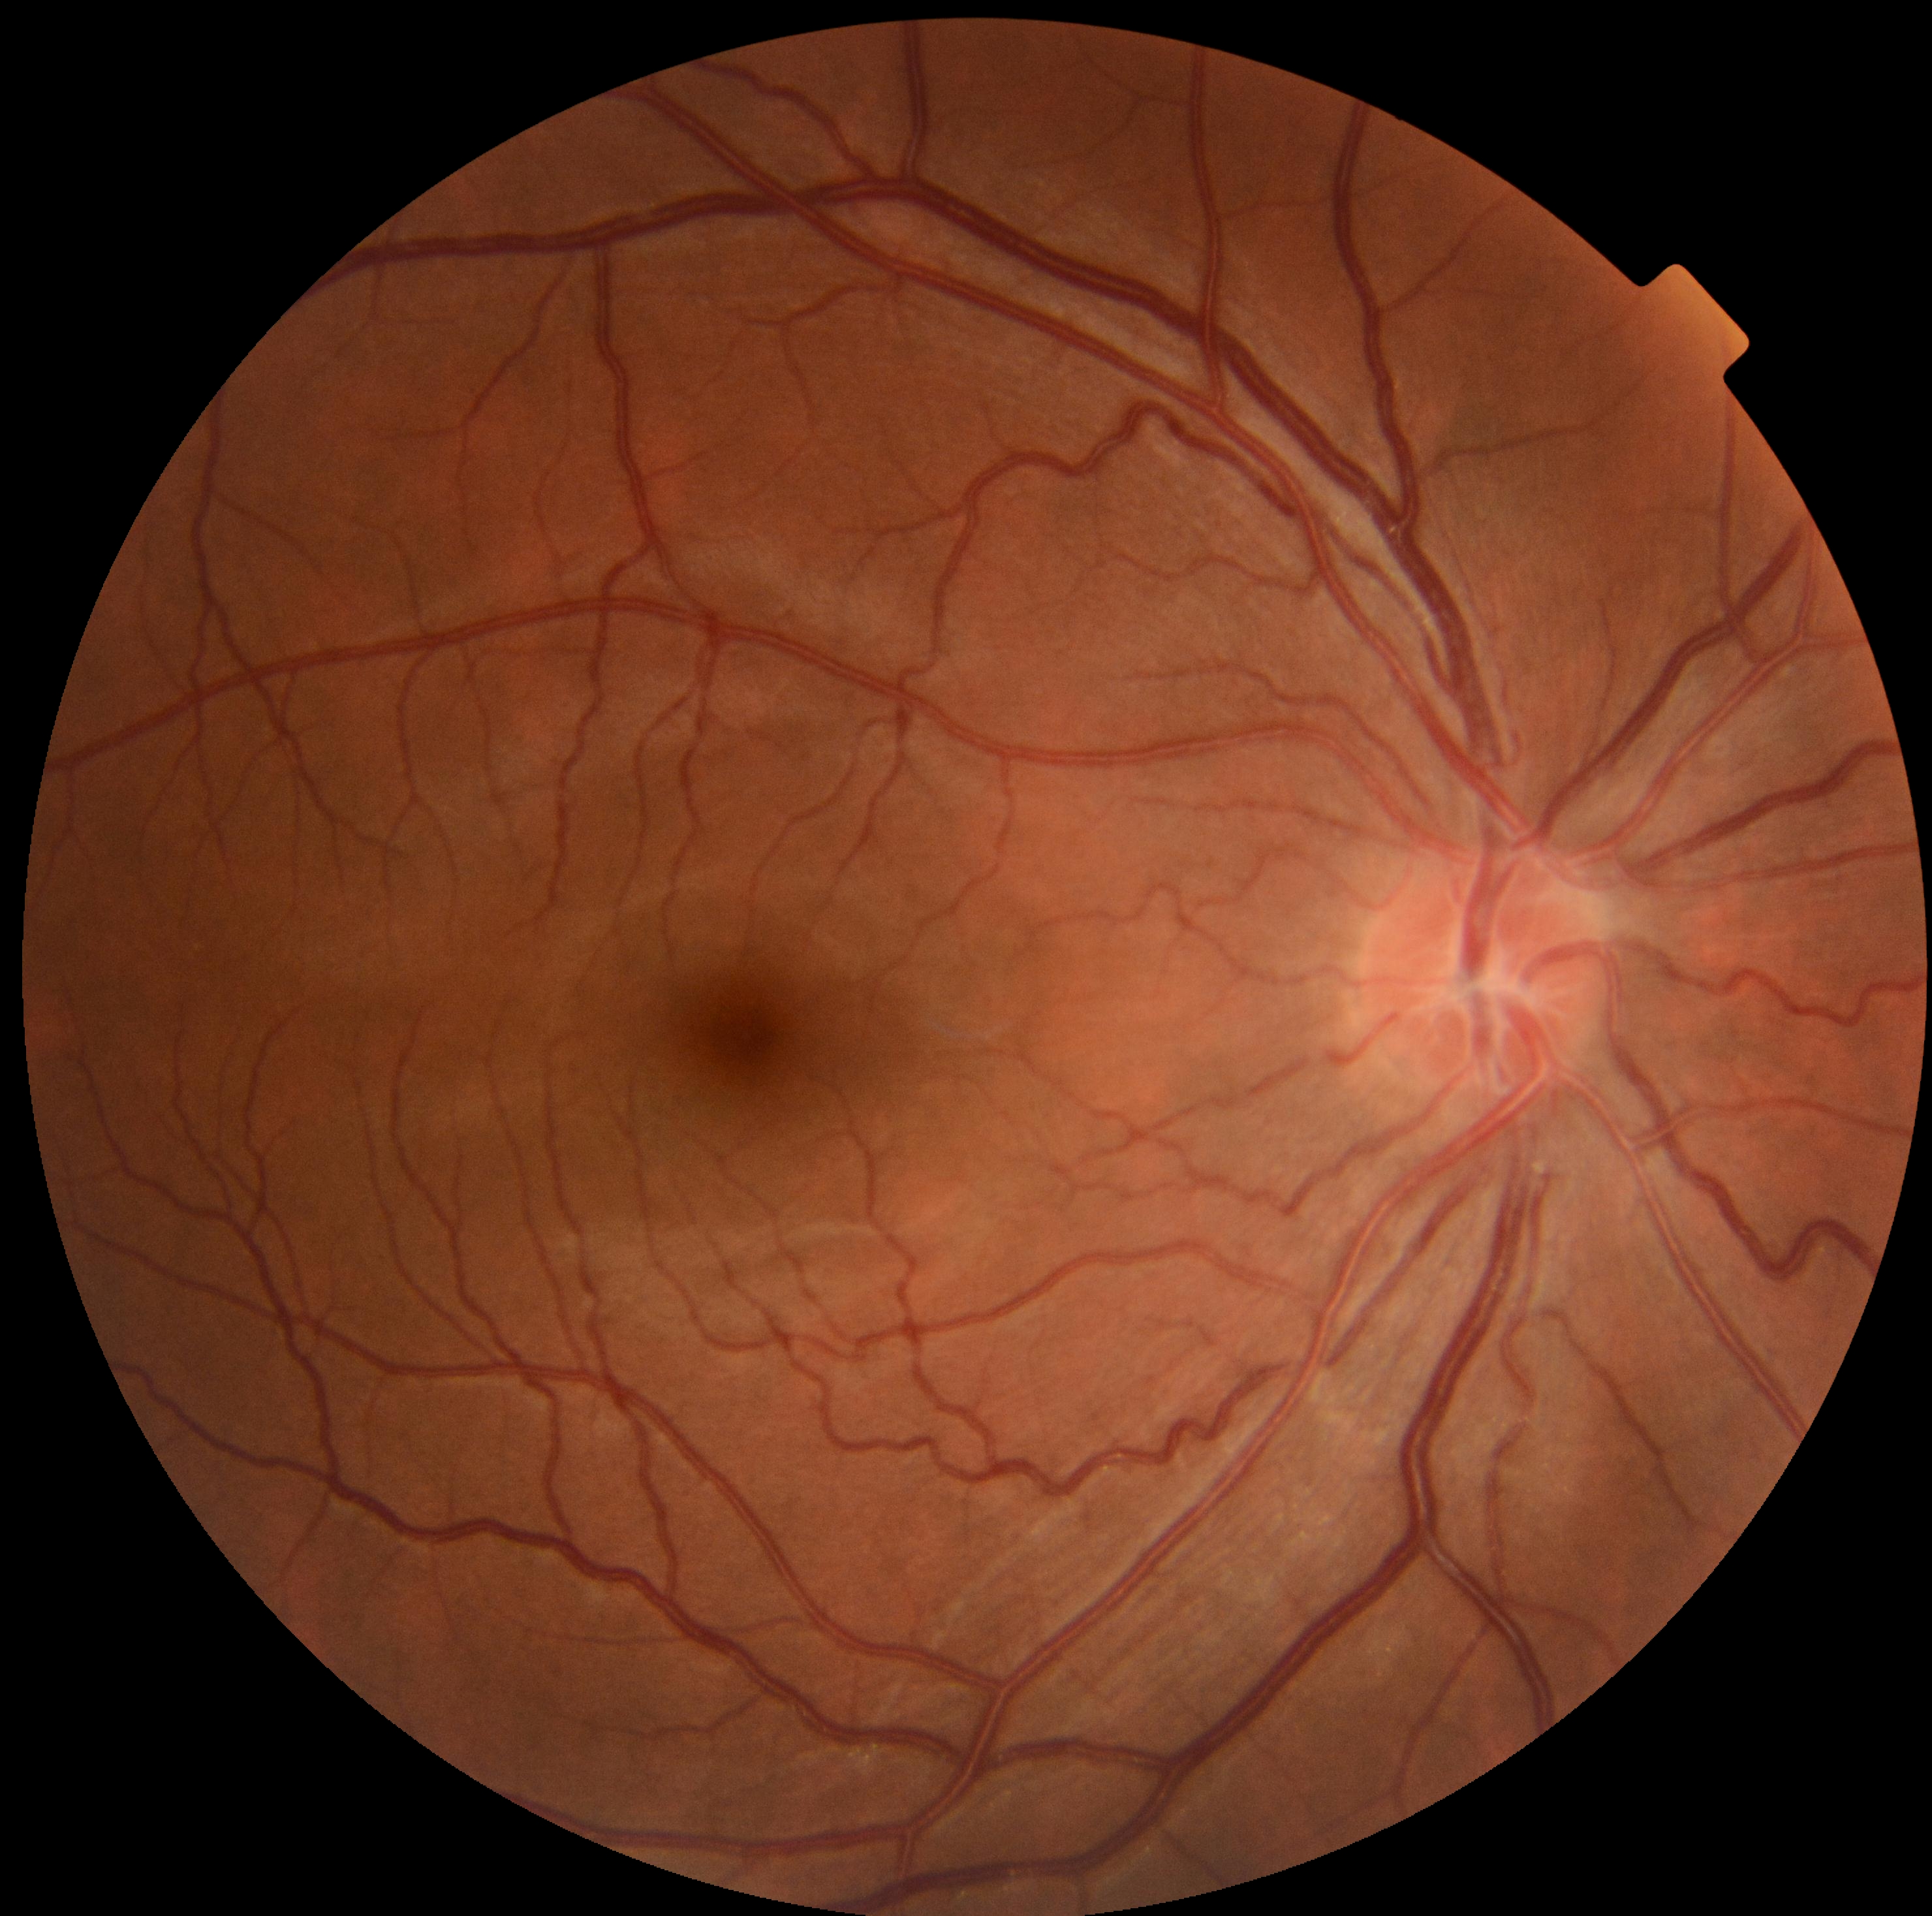 DR grade is no apparent diabetic retinopathy (0).